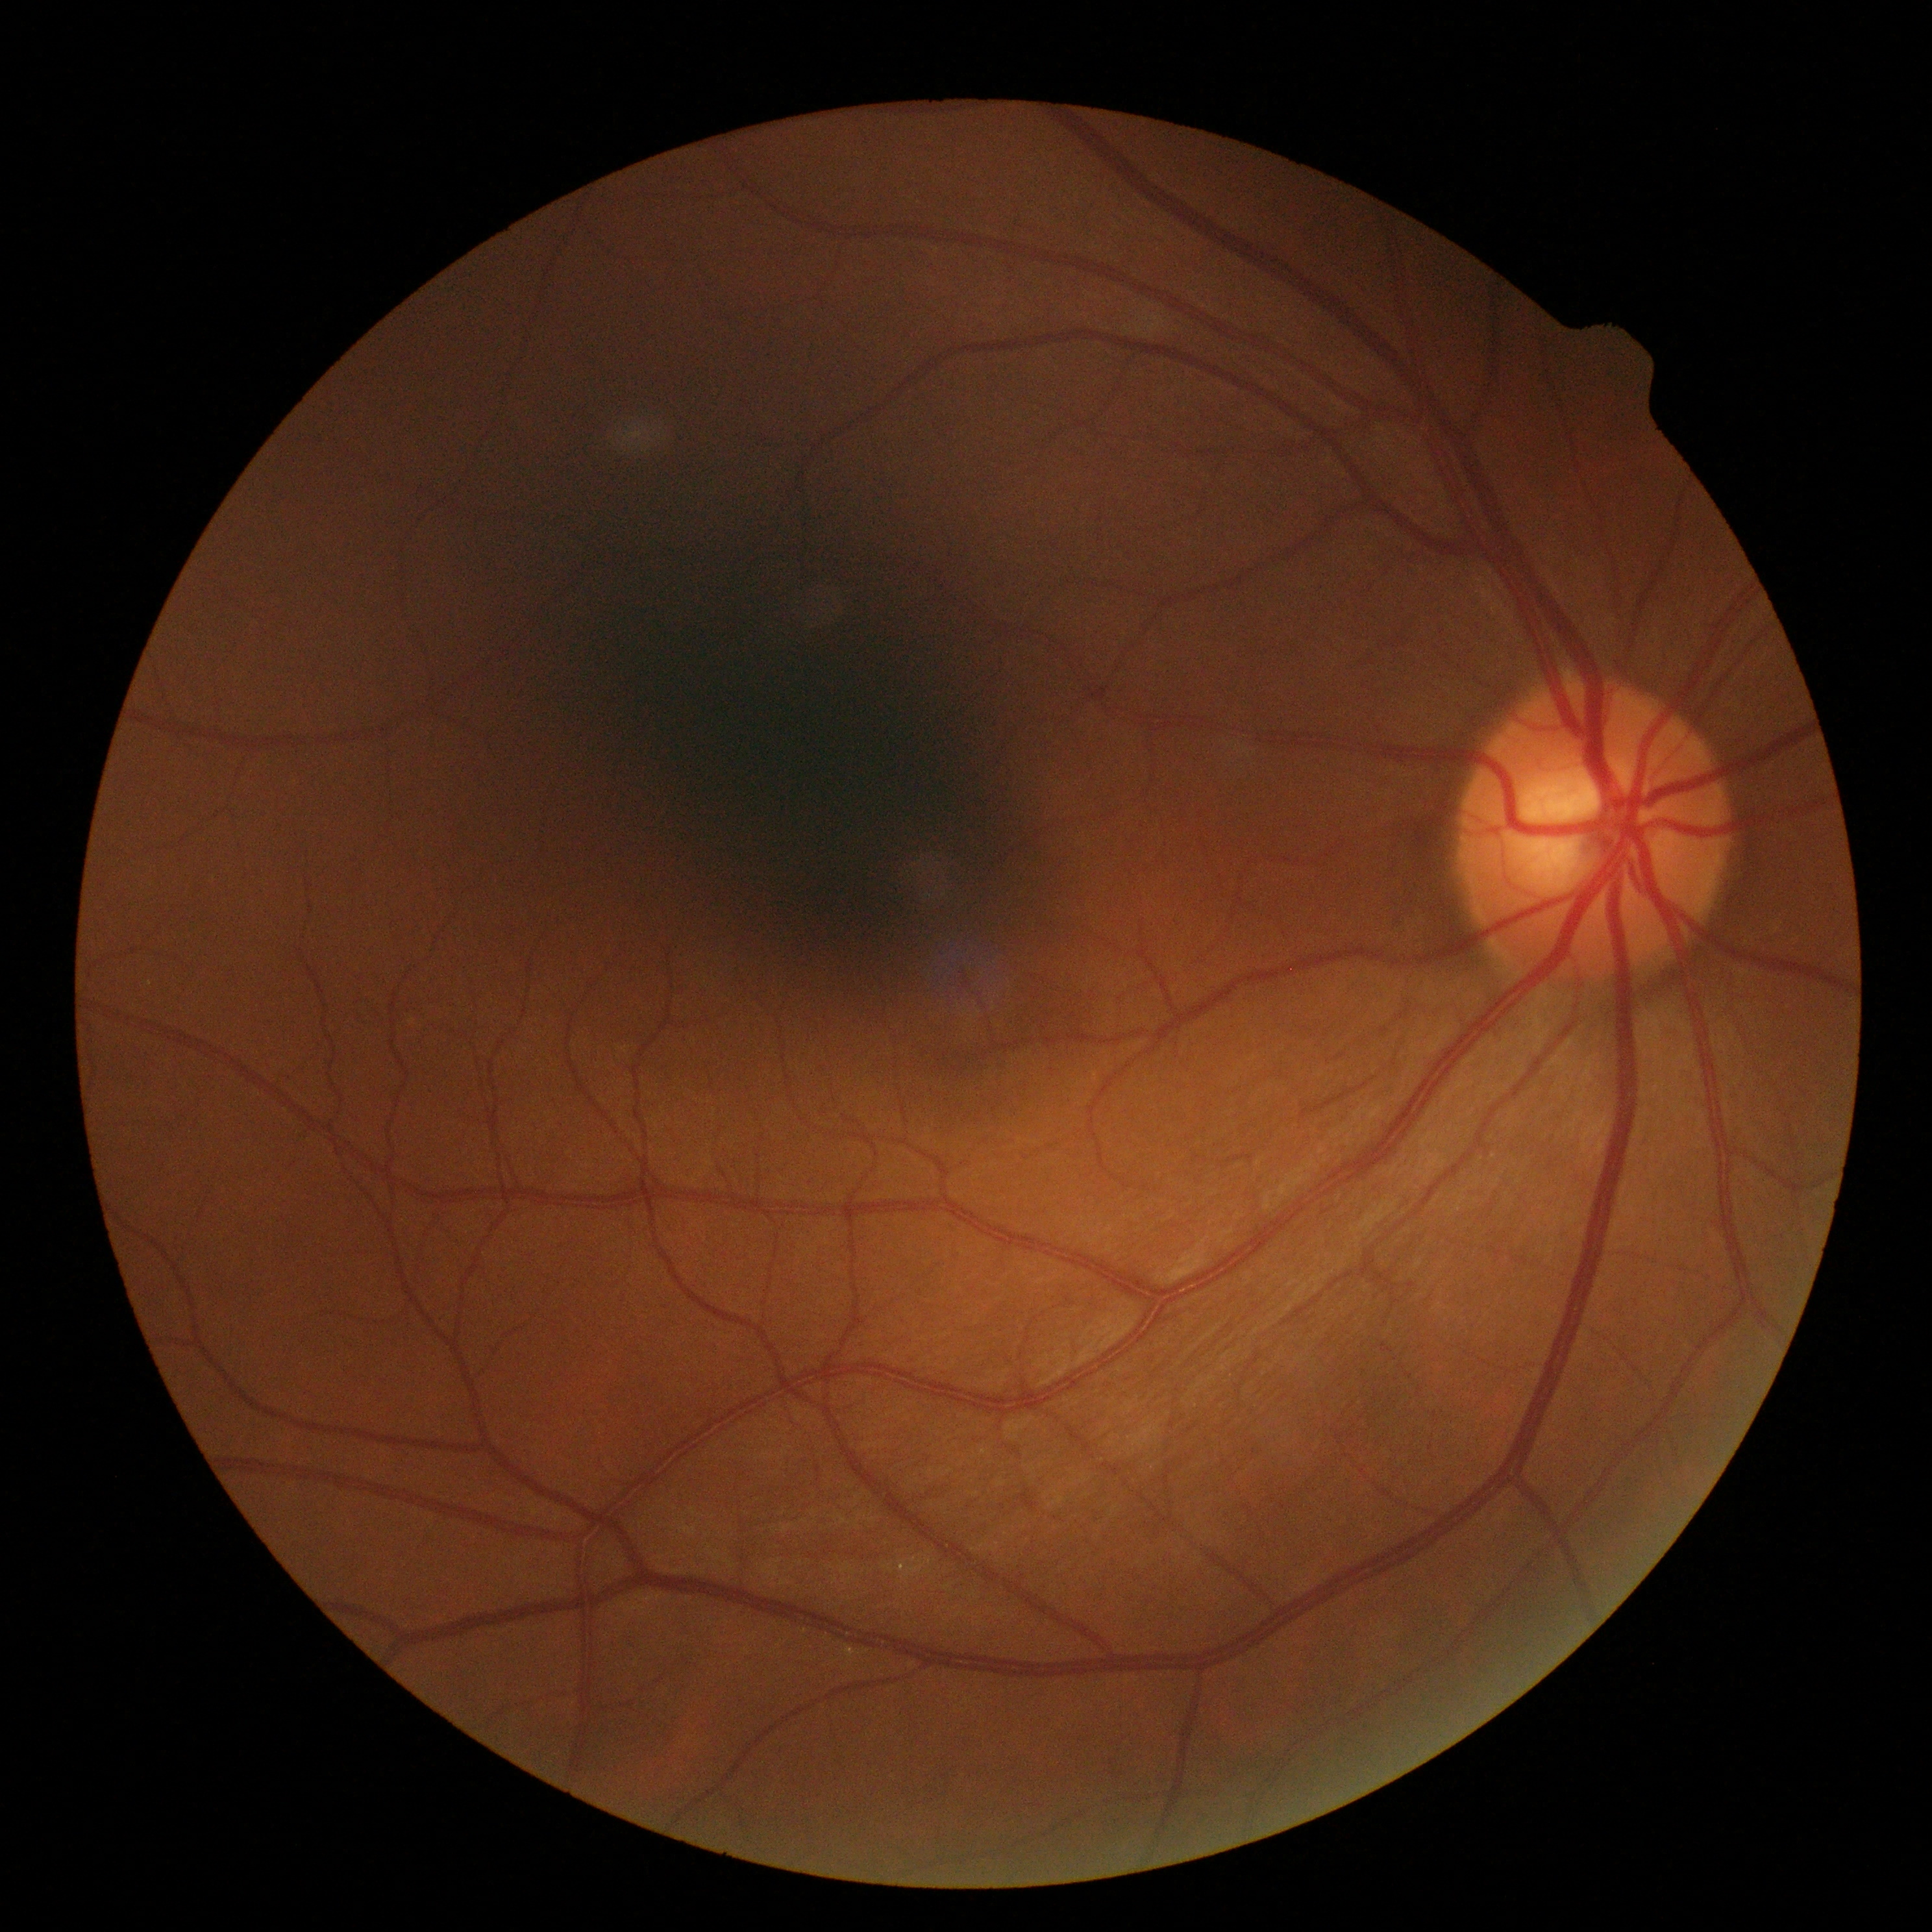 DR impression: no DR findings, diabetic retinopathy grade: 0/4.